Acquired with a NIDEK AFC-230; nonmydriatic; 848x848px; 45° field of view.
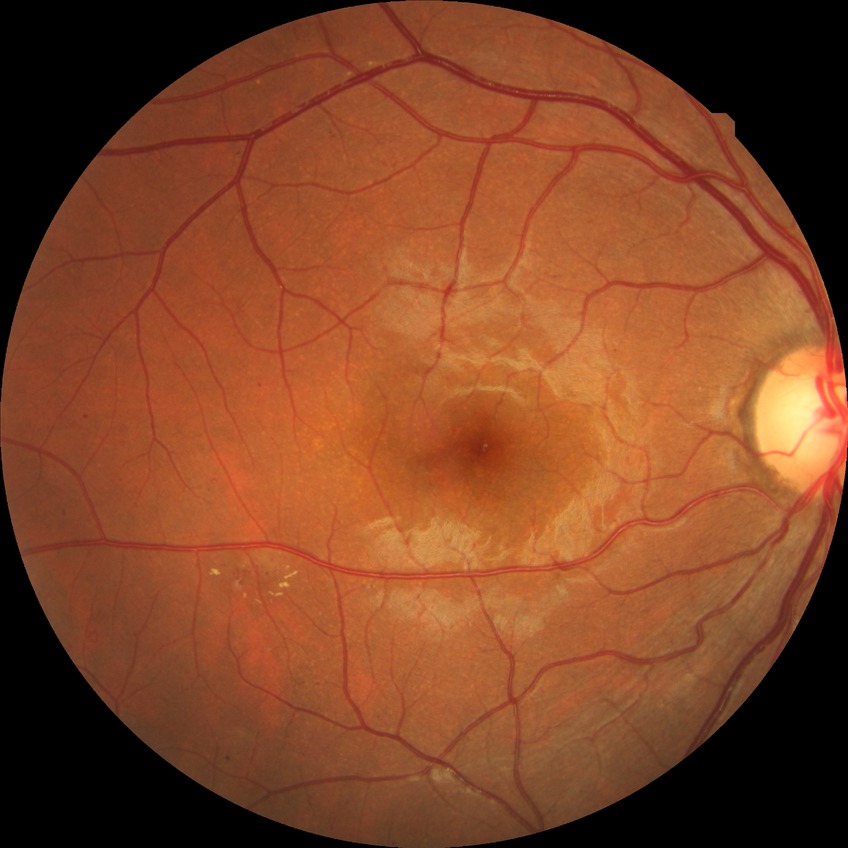 DR class@non-proliferative diabetic retinopathy, retinopathy grade@simple diabetic retinopathy.